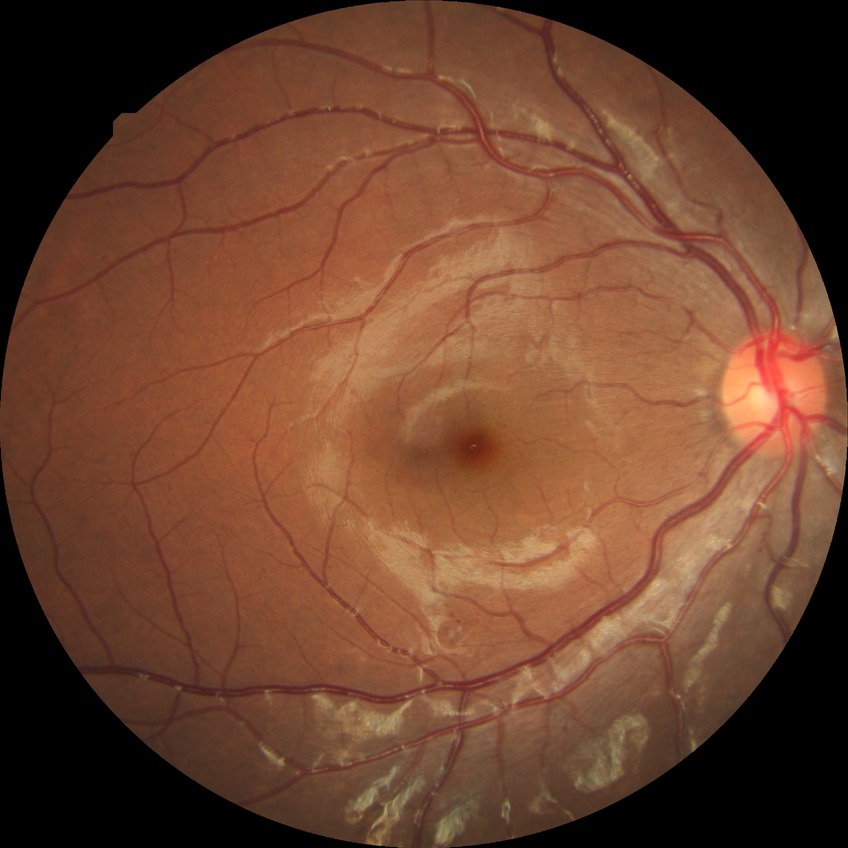   davis_grade: SDR